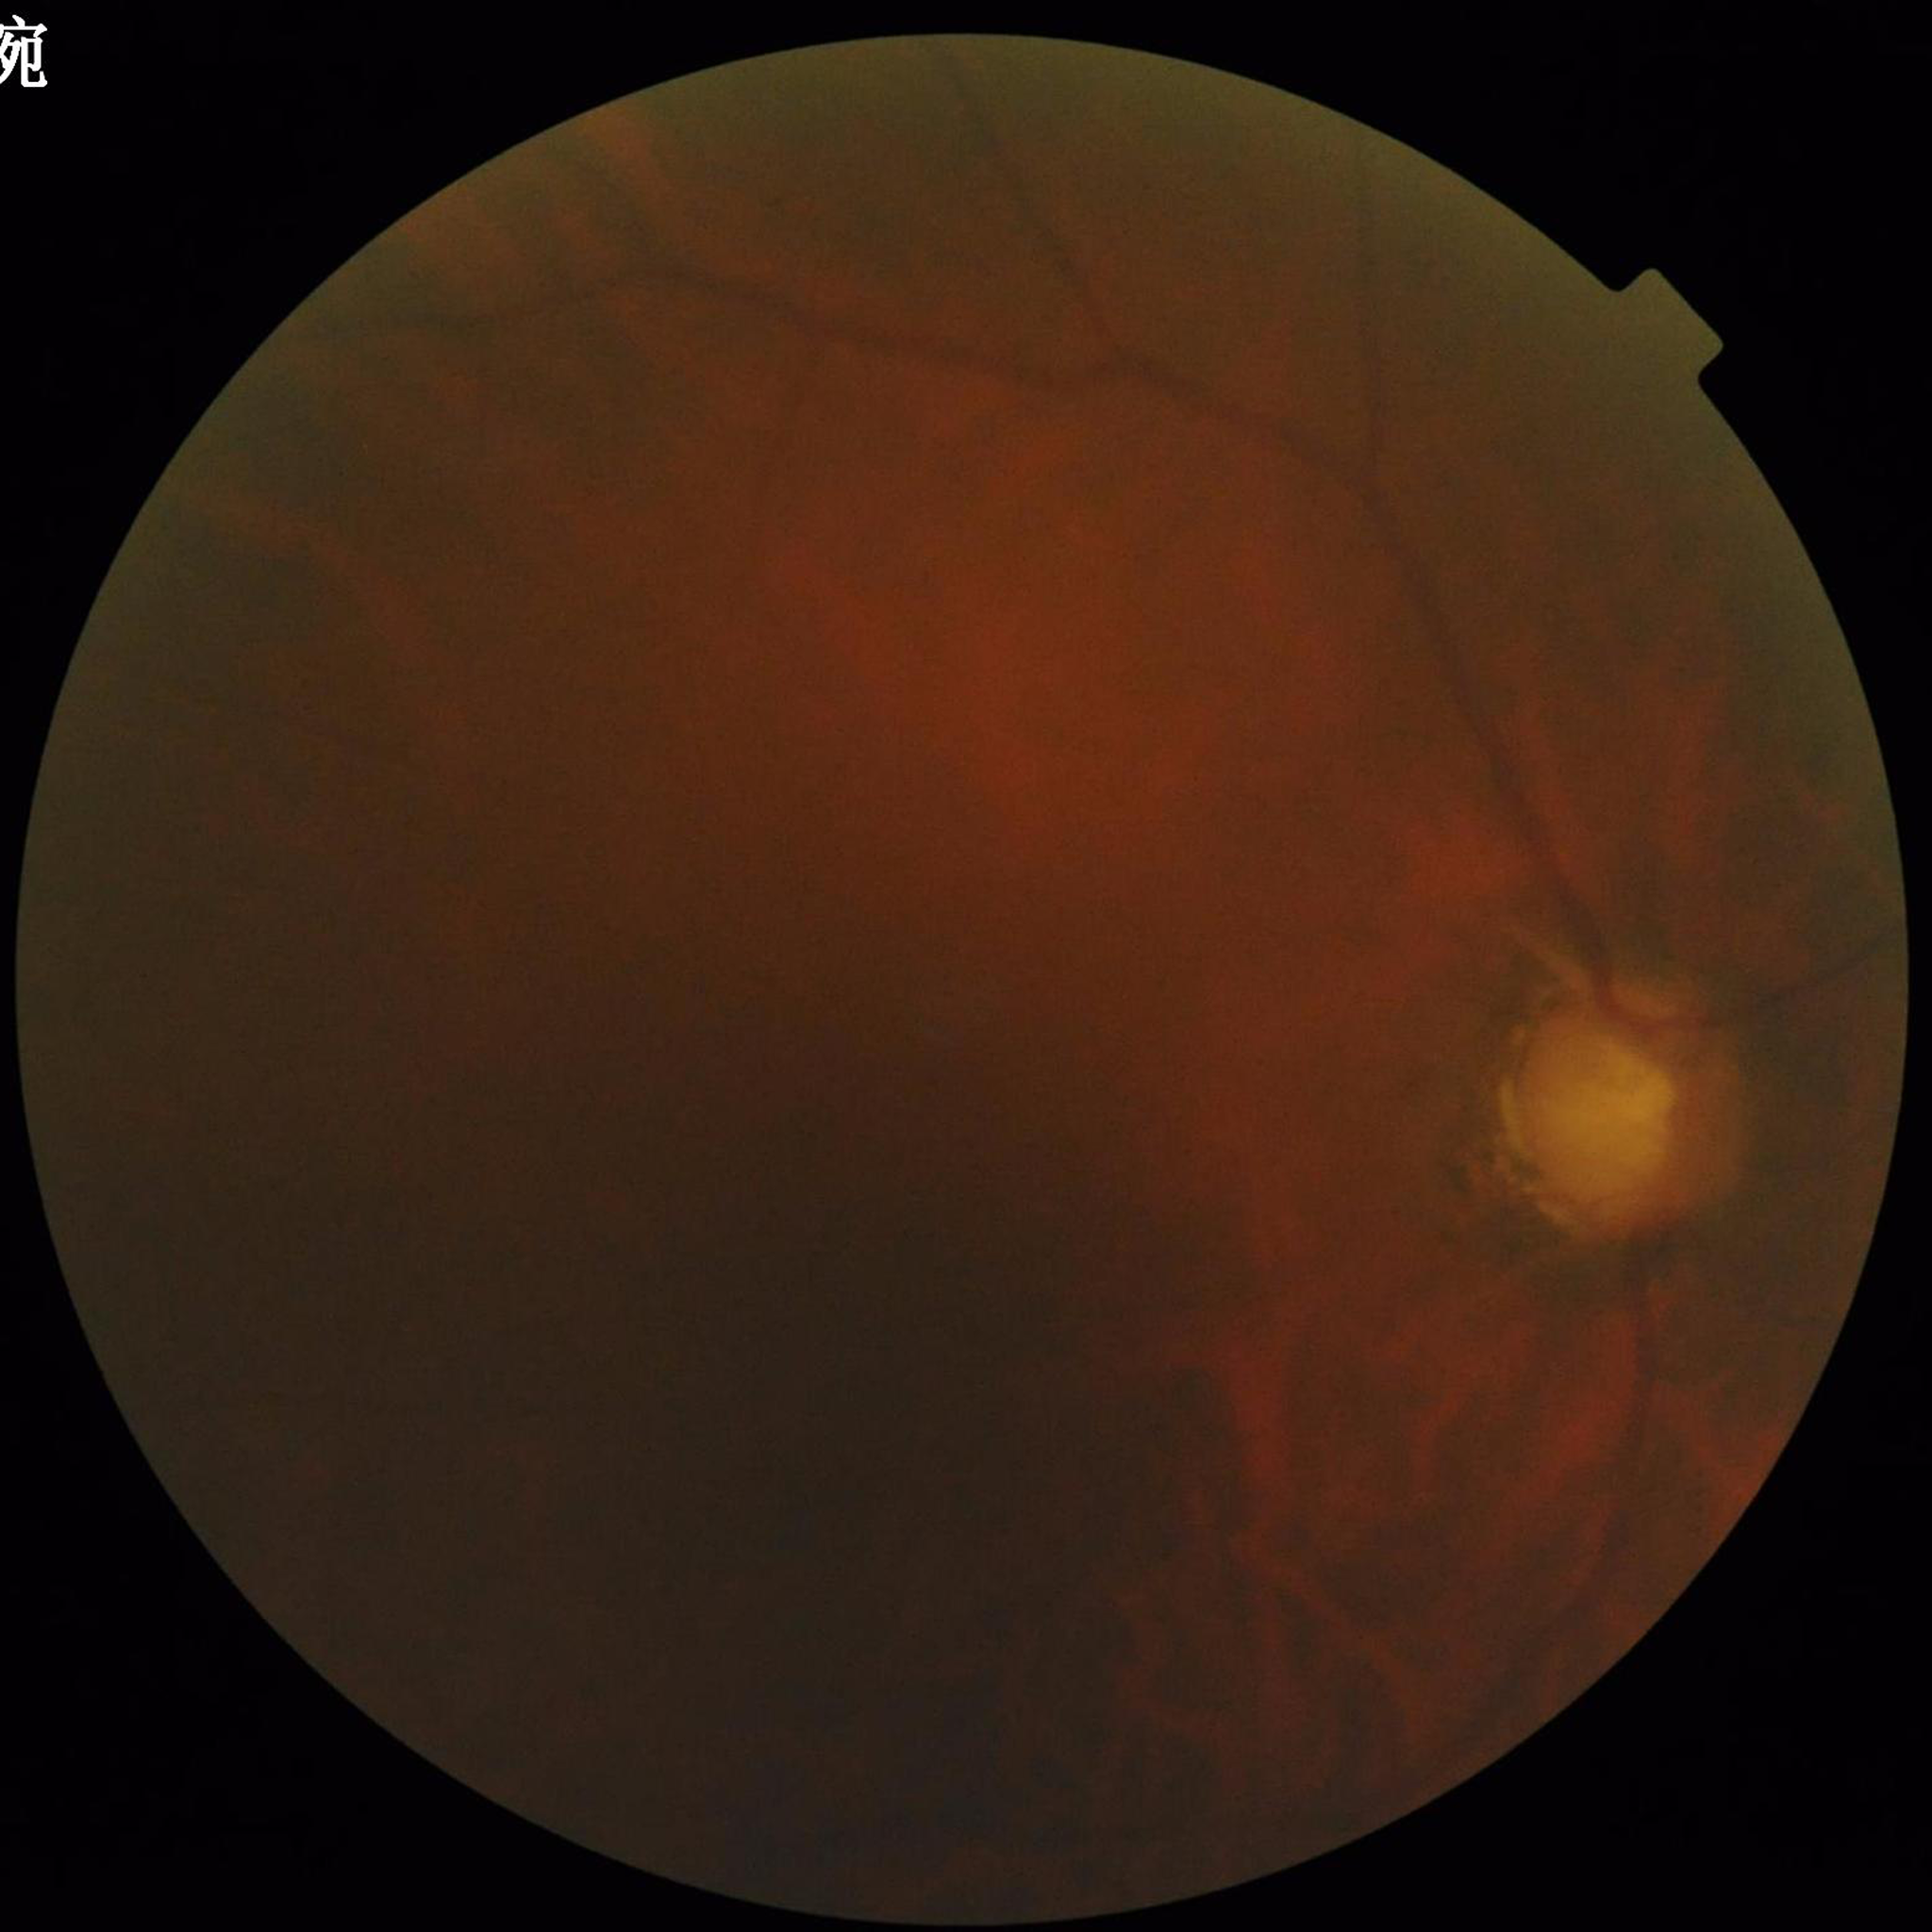

Quality assessment: poor — blur, illumination/color distortion, low contrast. Diagnosed with glaucoma.